Nonmydriatic fundus photograph, diabetic retinopathy graded by the modified Davis classification
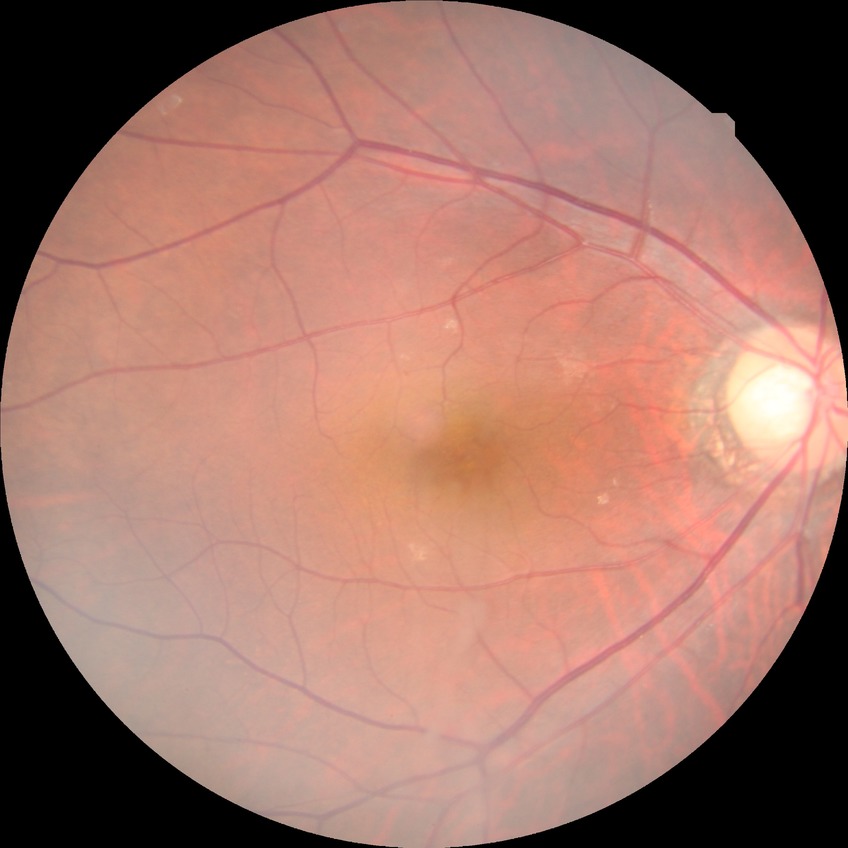 Annotations:
* diabetic retinopathy (DR) — NDR (no diabetic retinopathy)